Wide-field contact fundus photograph of an infant
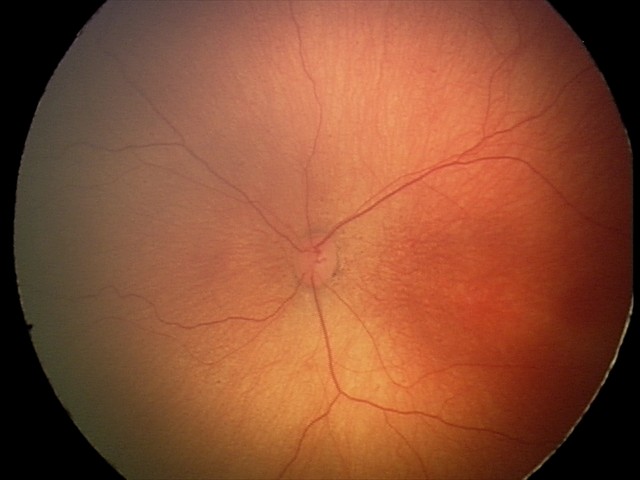
Without plus disease. Screening series with ROP stage 1.